Optic disc-centered. Axial length: 22.55 mm. Corneal thickness: 516 µm. Age 81:
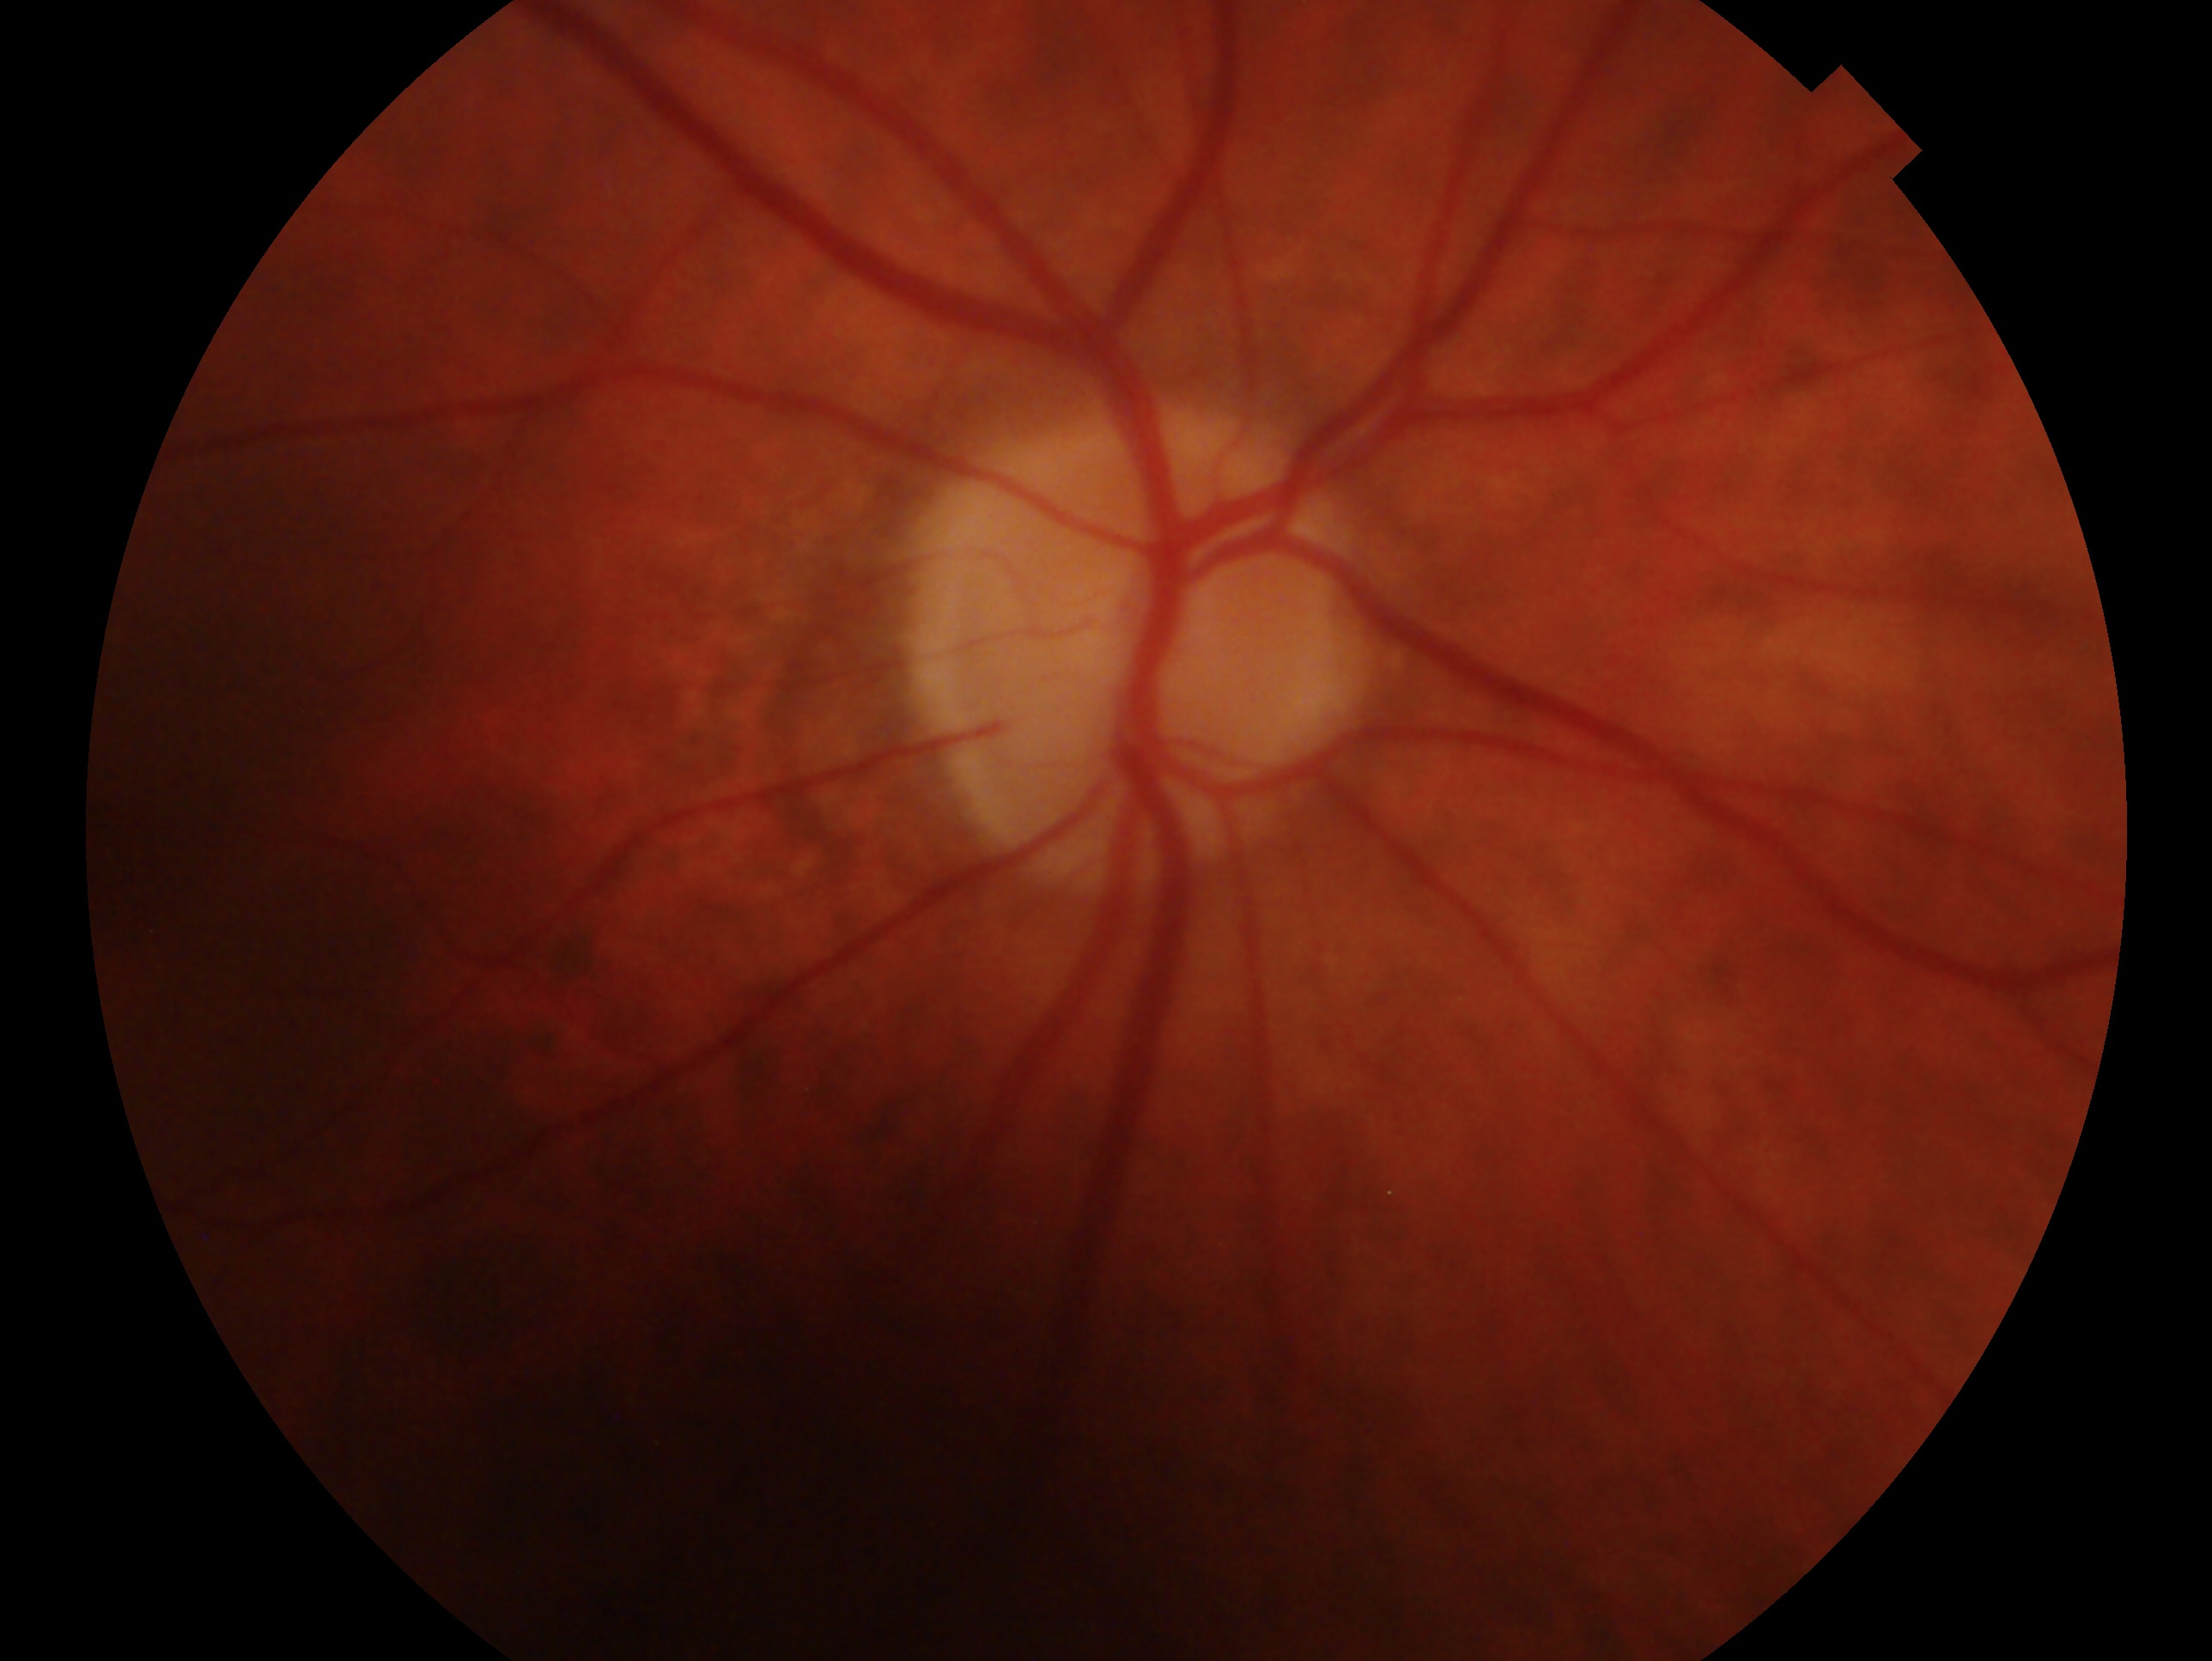 This is the right eye. Glaucoma status: no signs of glaucoma.